Color fundus image — 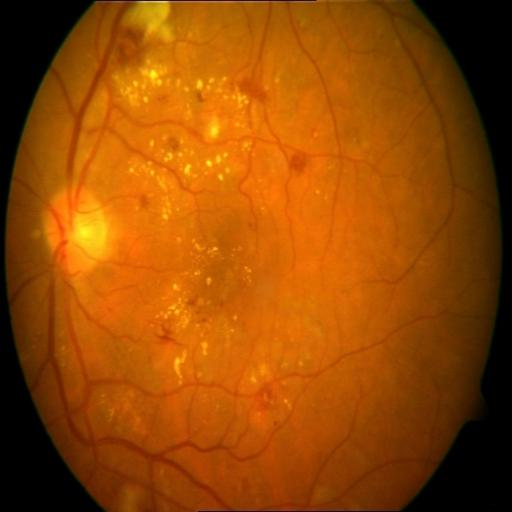
Showing cotton wool spots (CWS), microaneurysms (MCA), hemorrhagic retinopathy (HR) & exudation (EDN).